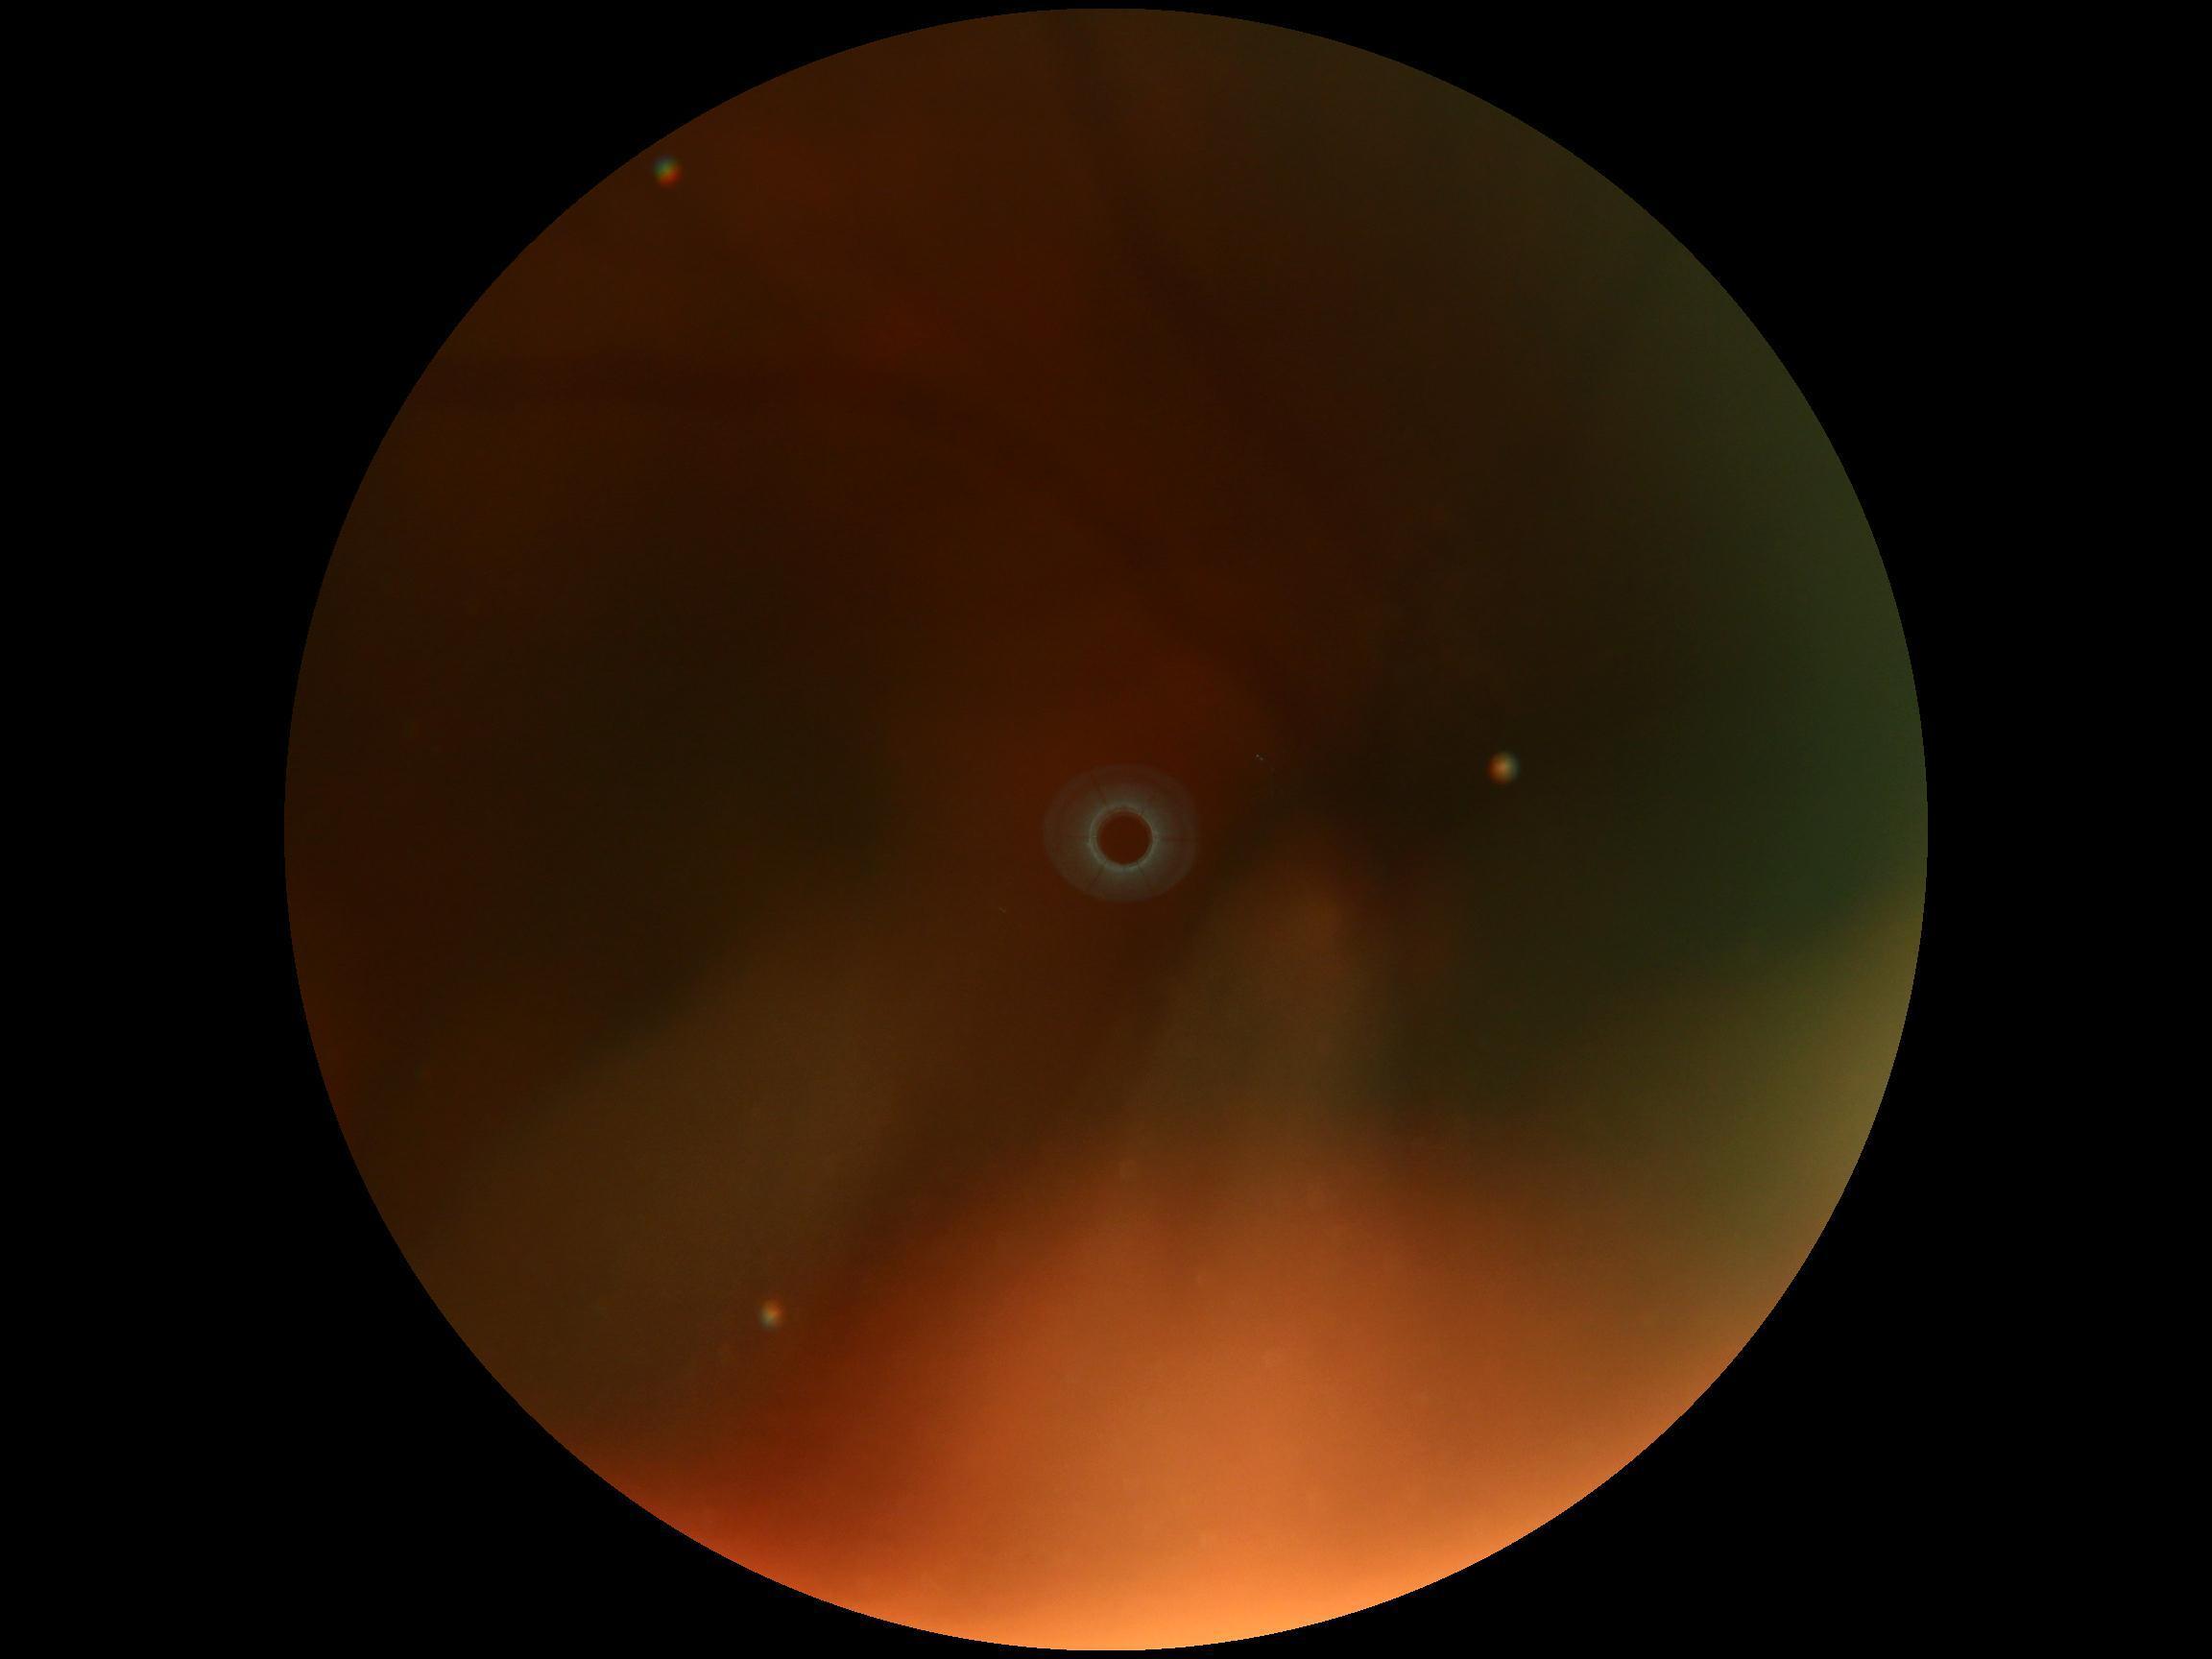
Retinopathy: ungradable. Image quality is insufficient for diabetic retinopathy assessment.